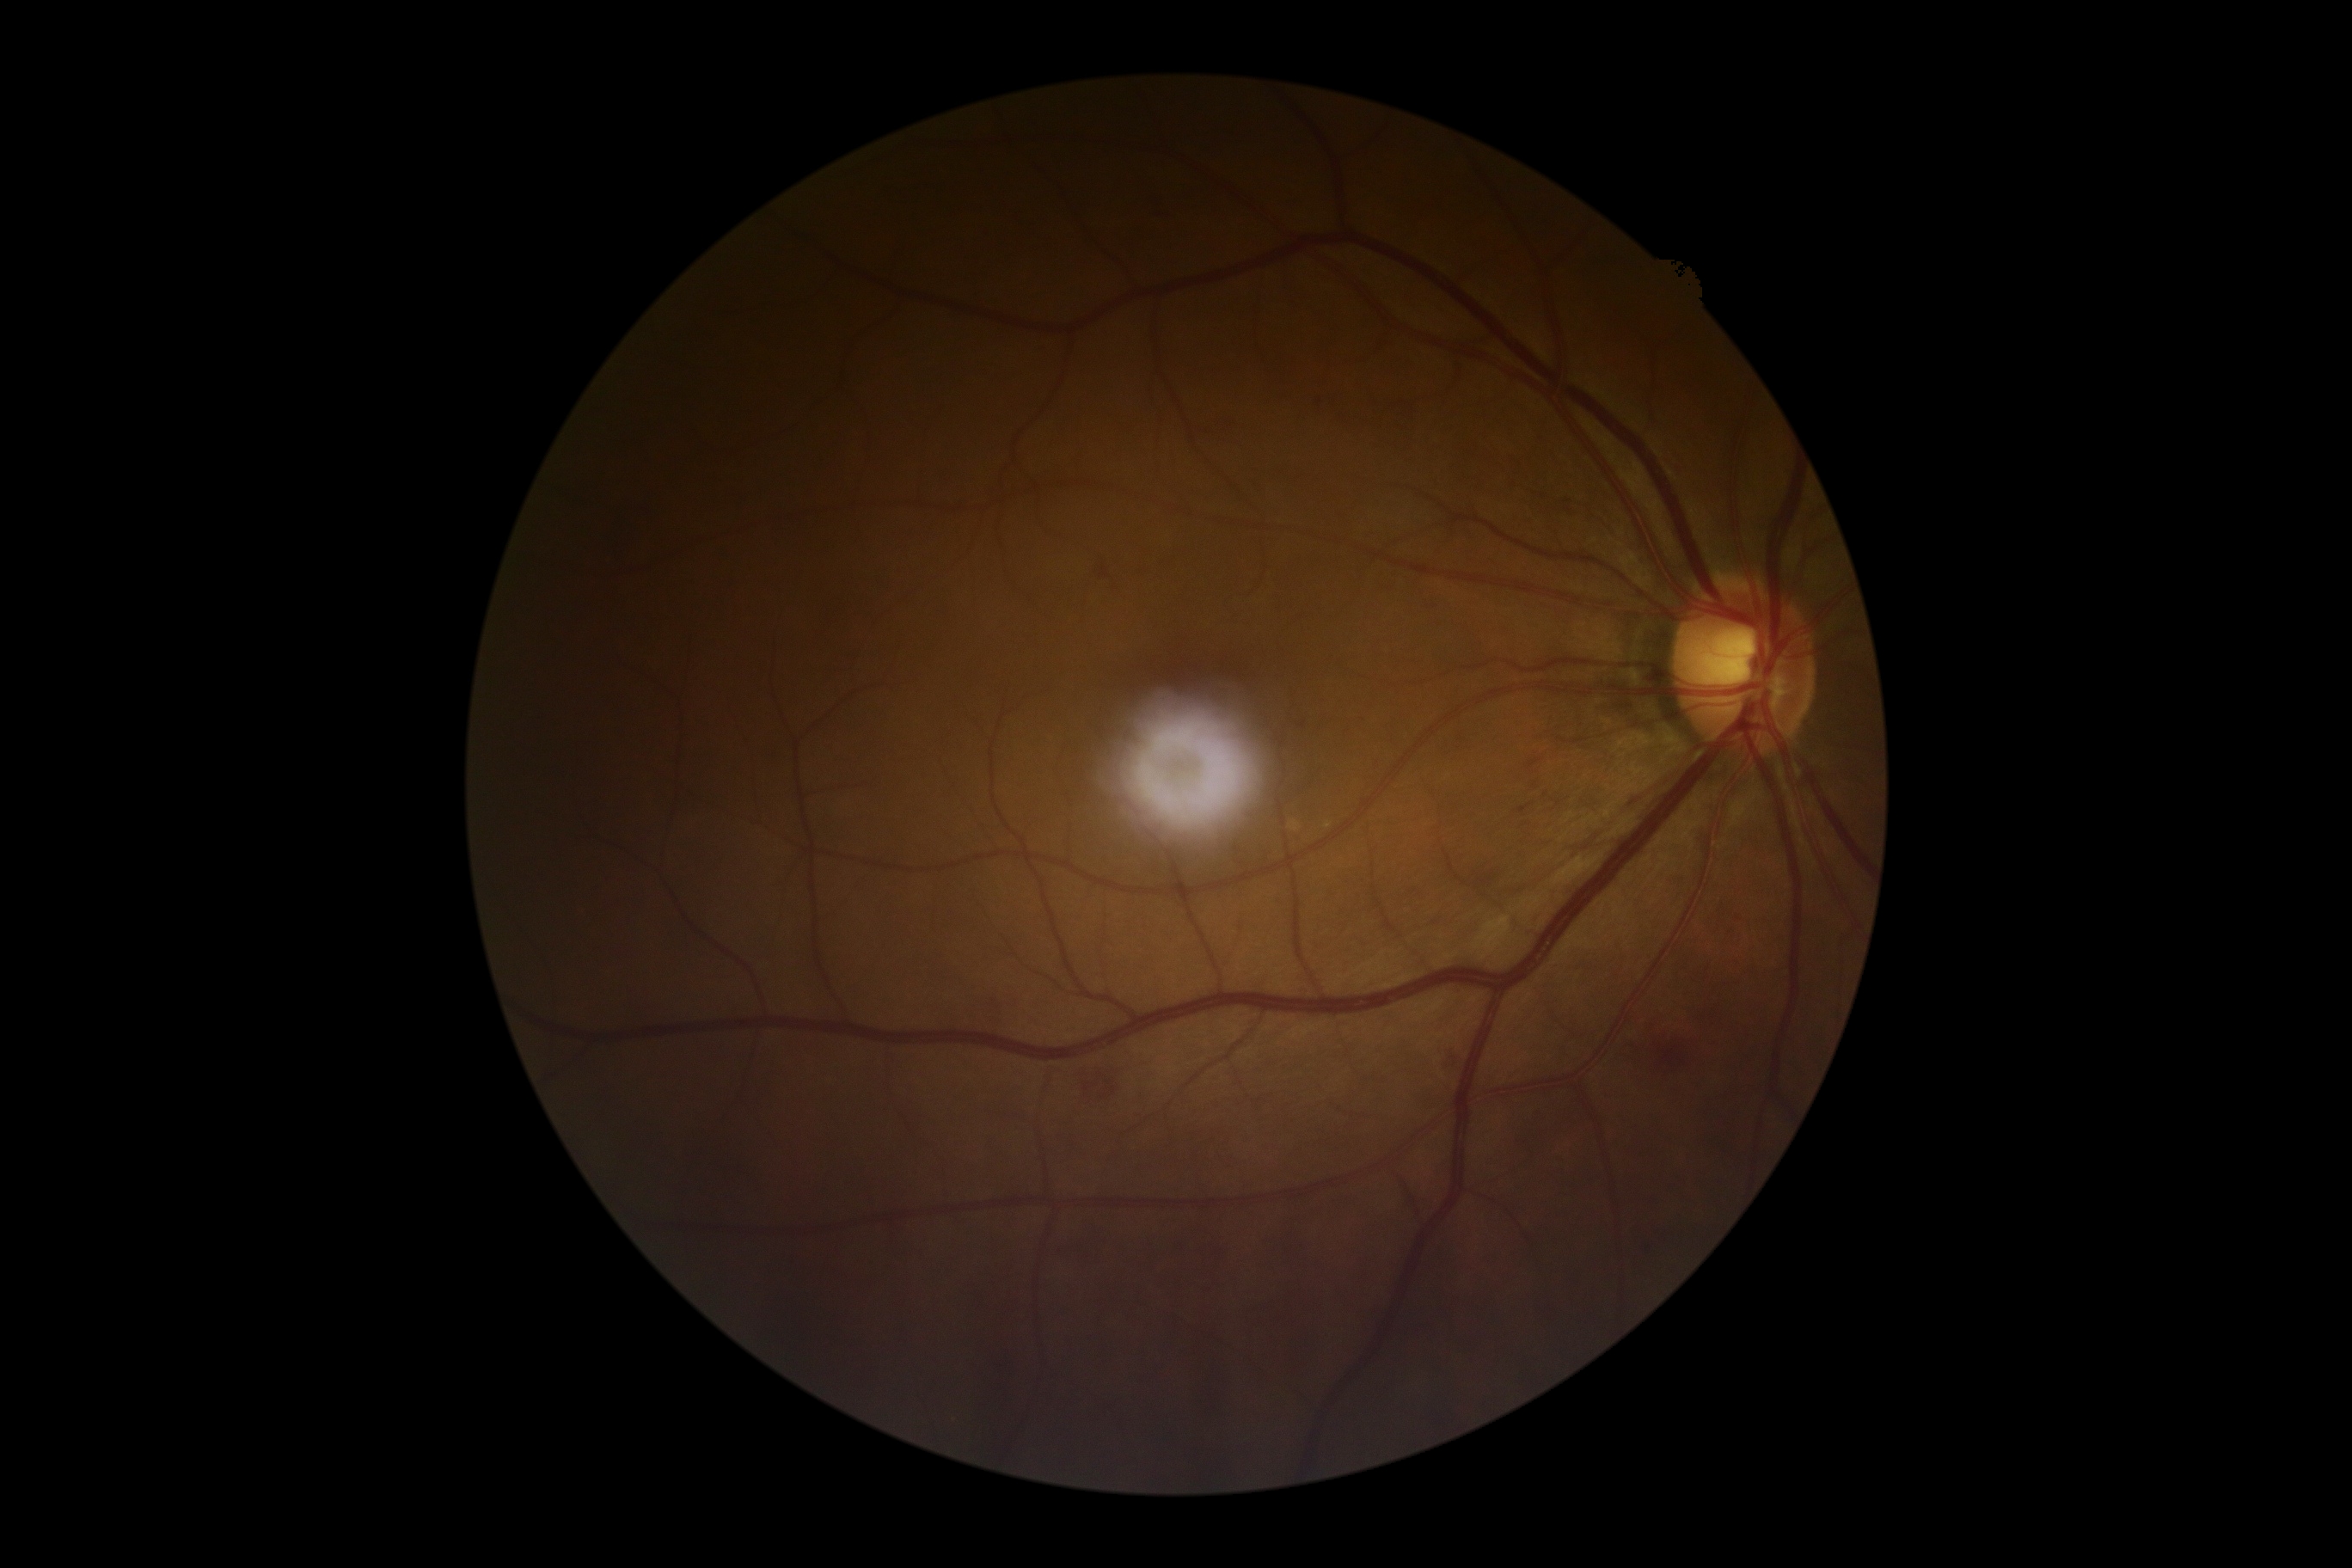
Retinopathy grade: 2 (moderate NPDR). Disease class: non-proliferative diabetic retinopathy.